Wide-field fundus photograph of an infant: 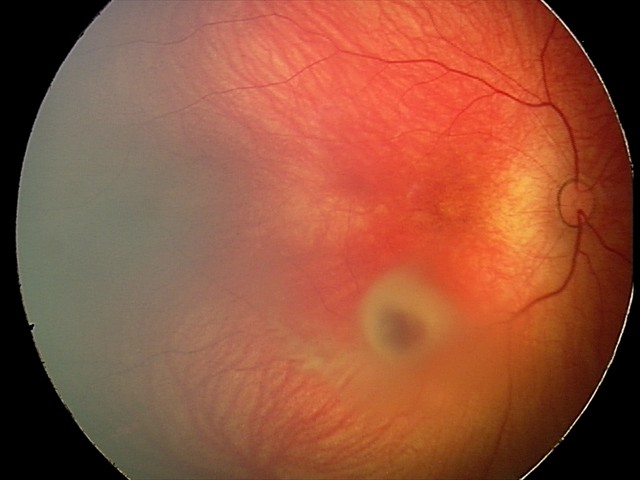

Screening series with retinal hemorrhages.